2212x1659px.
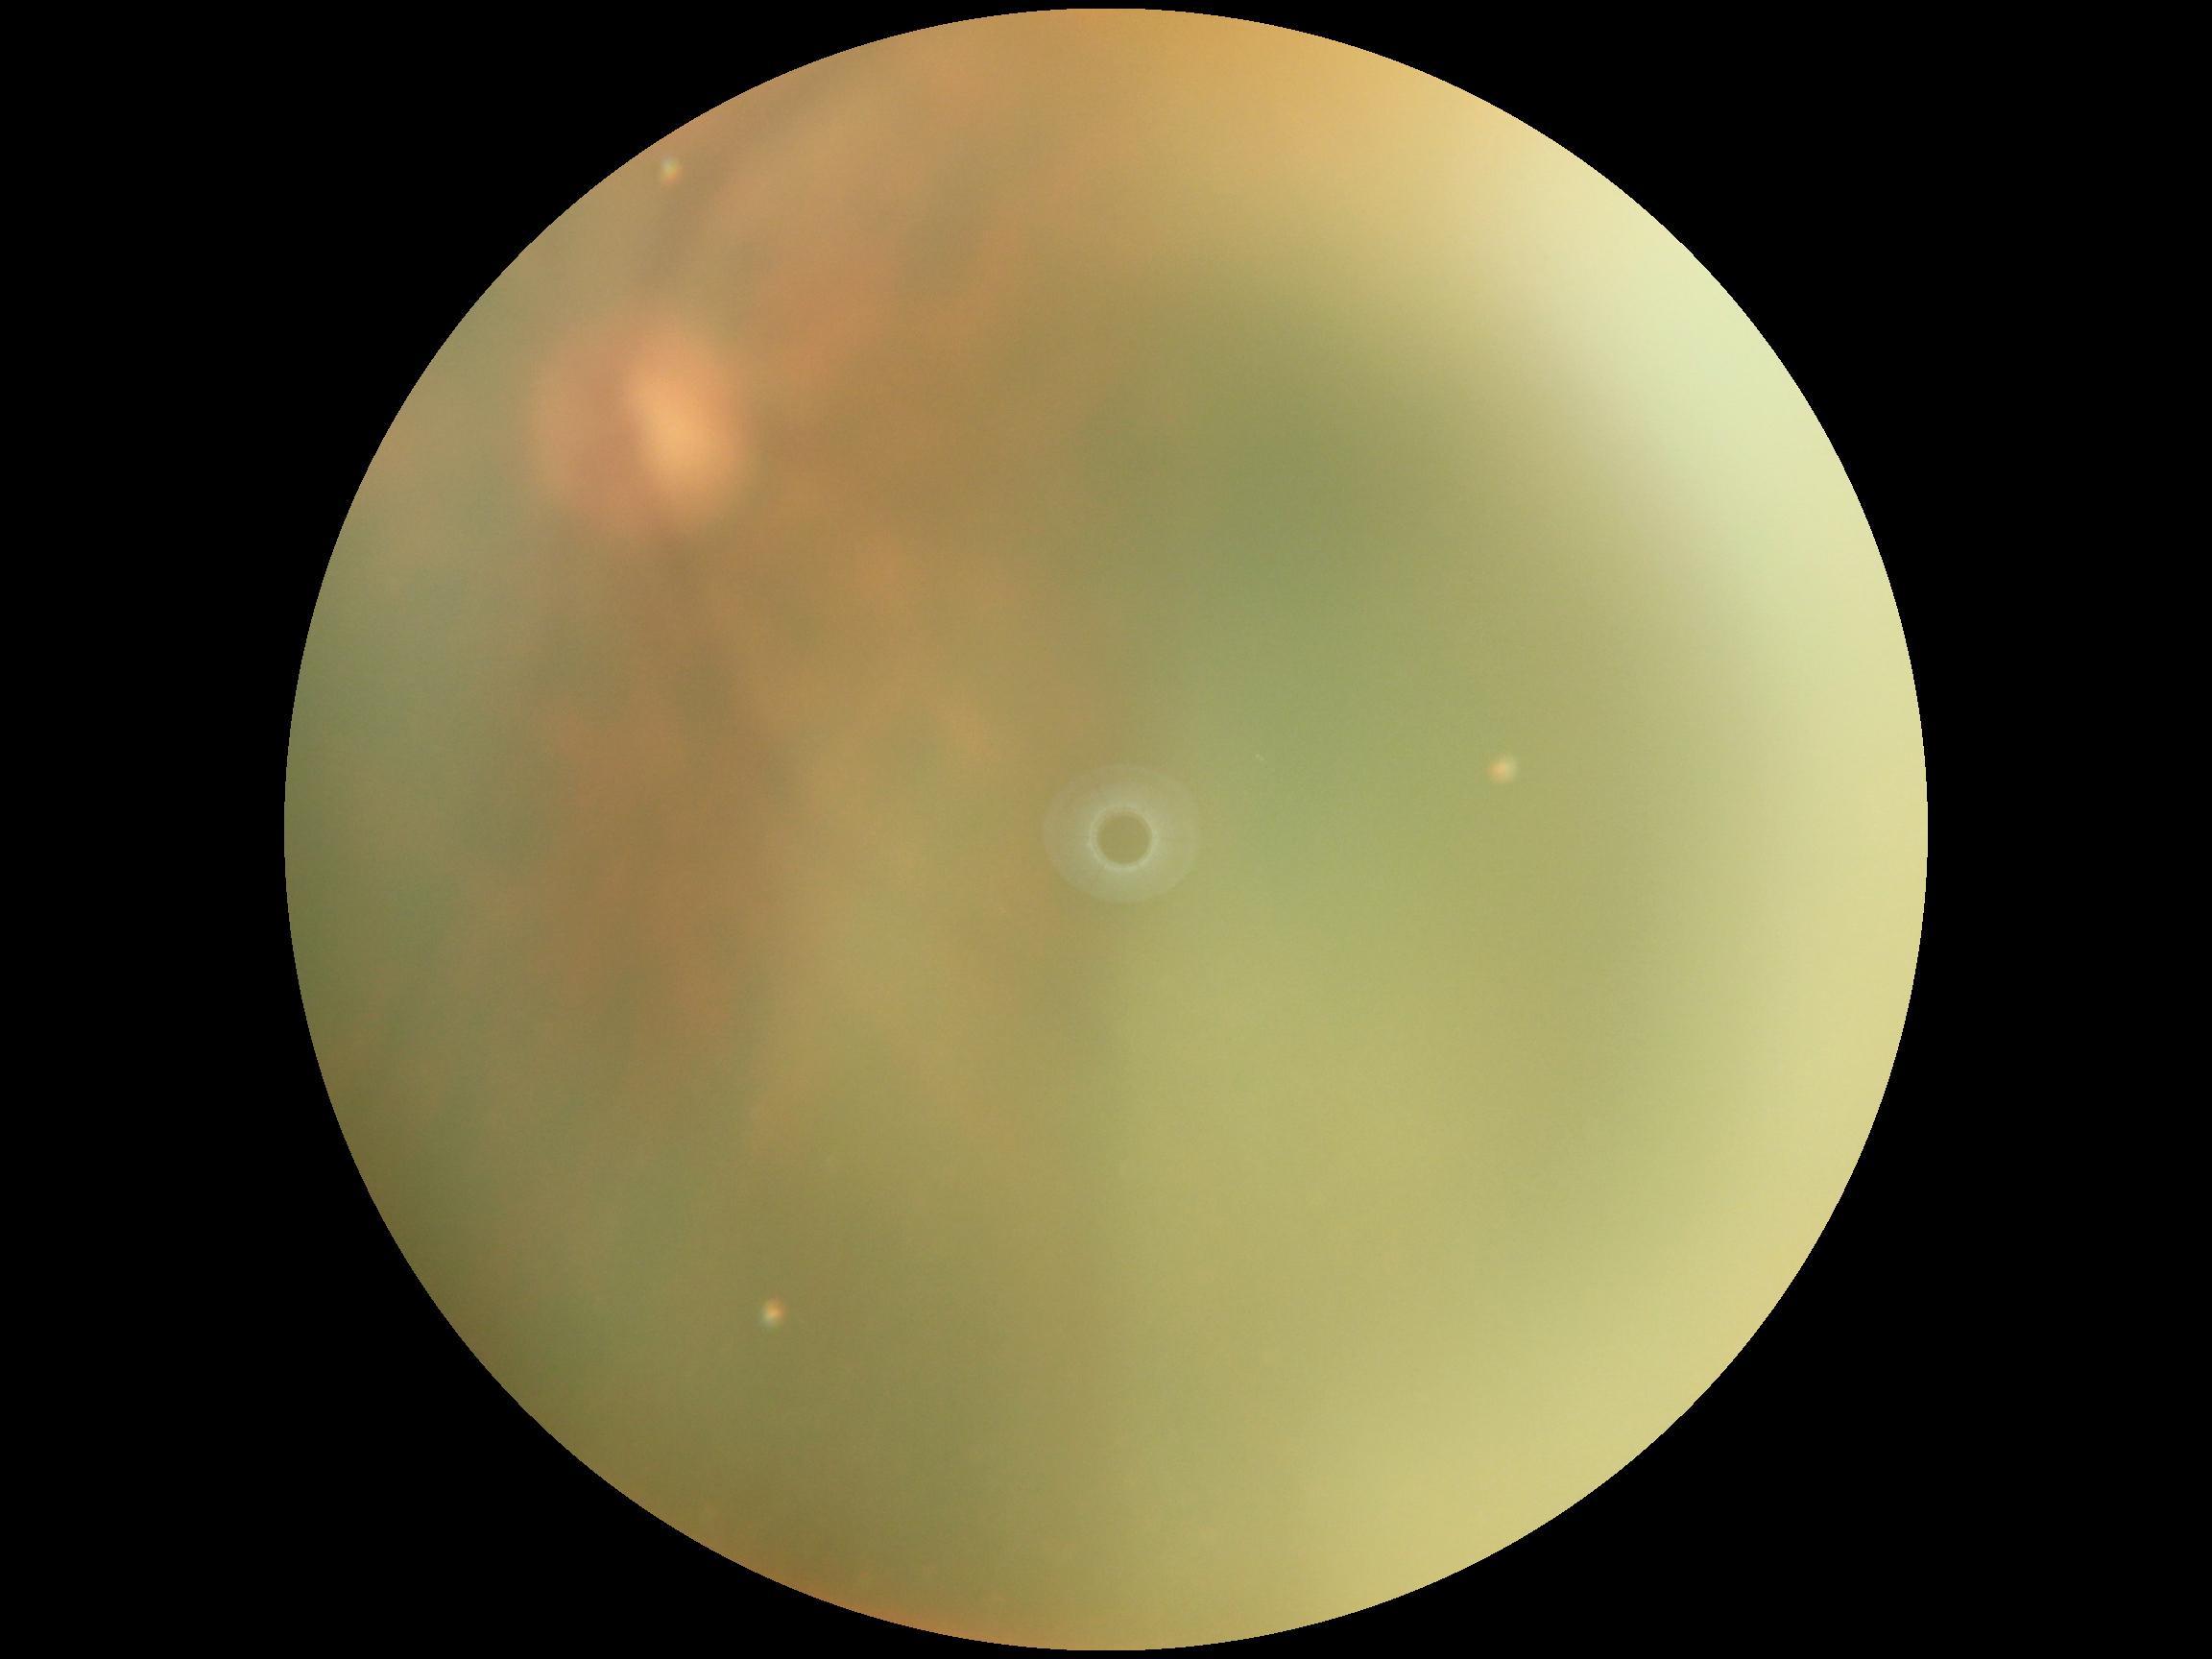 Diabetic retinopathy (DR) is ungradable.